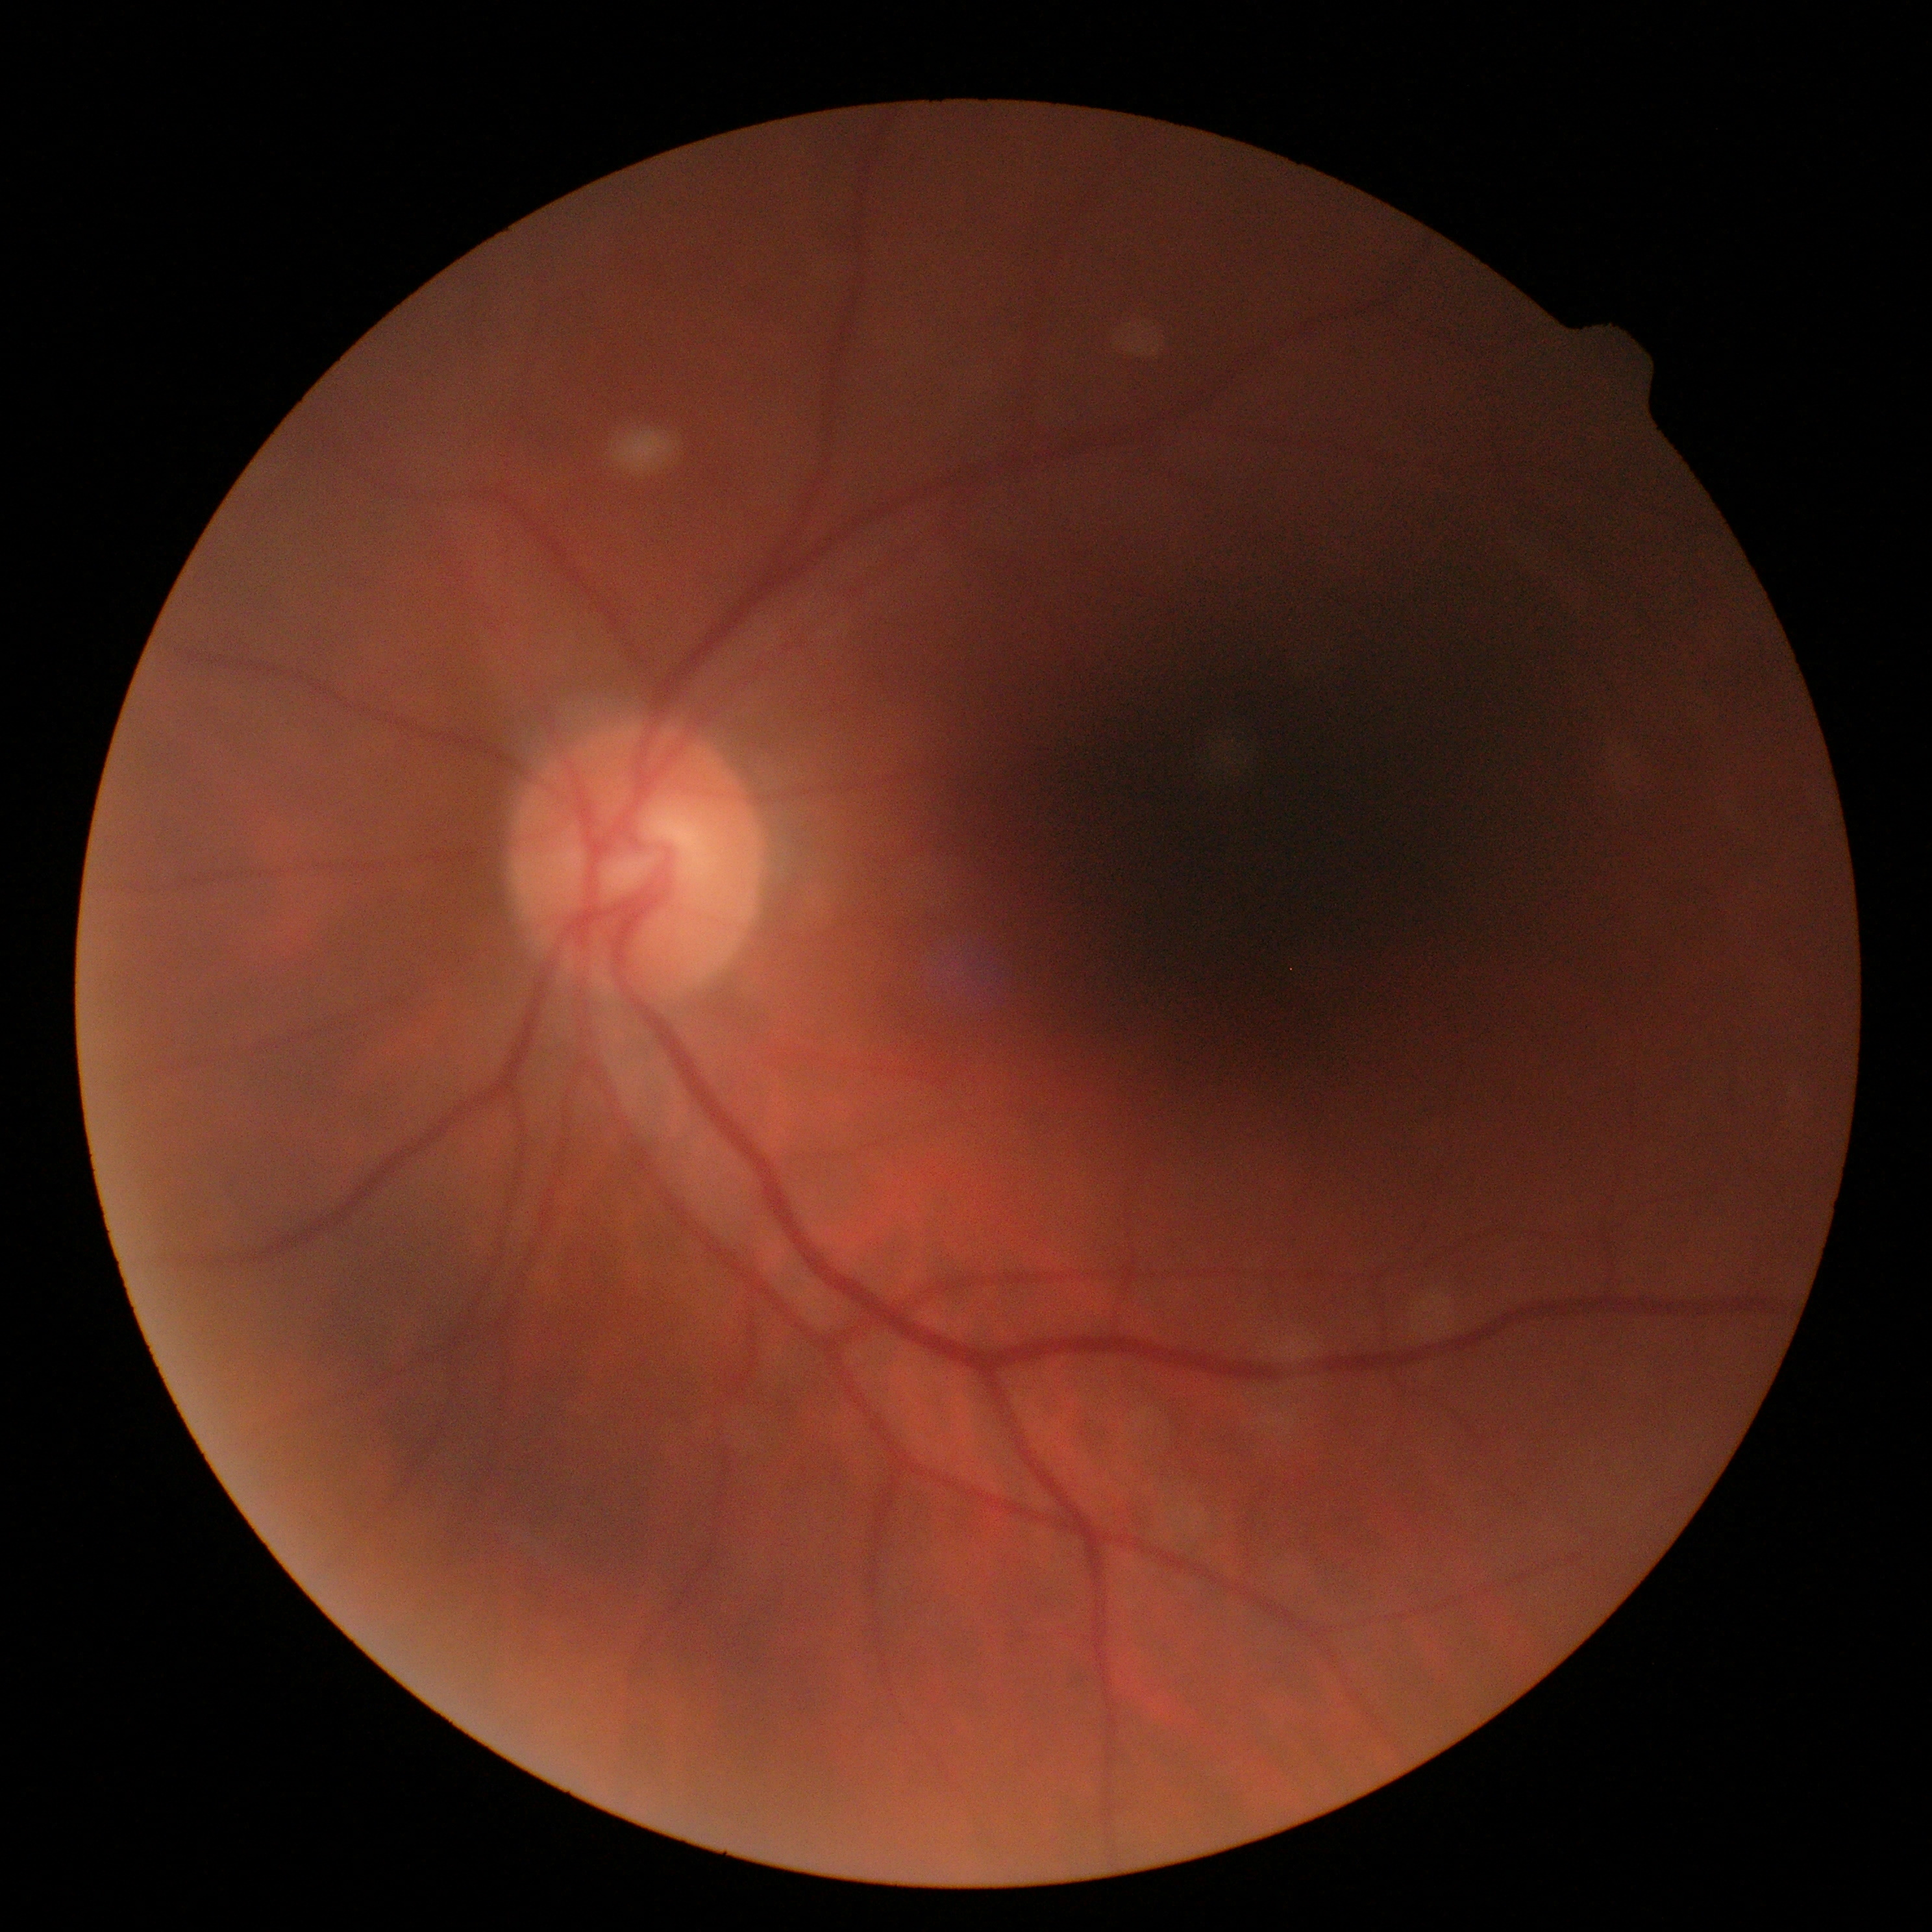 DR: no apparent retinopathy (grade 0) — no visible signs of diabetic retinopathy.
No apparent diabetic retinopathy.